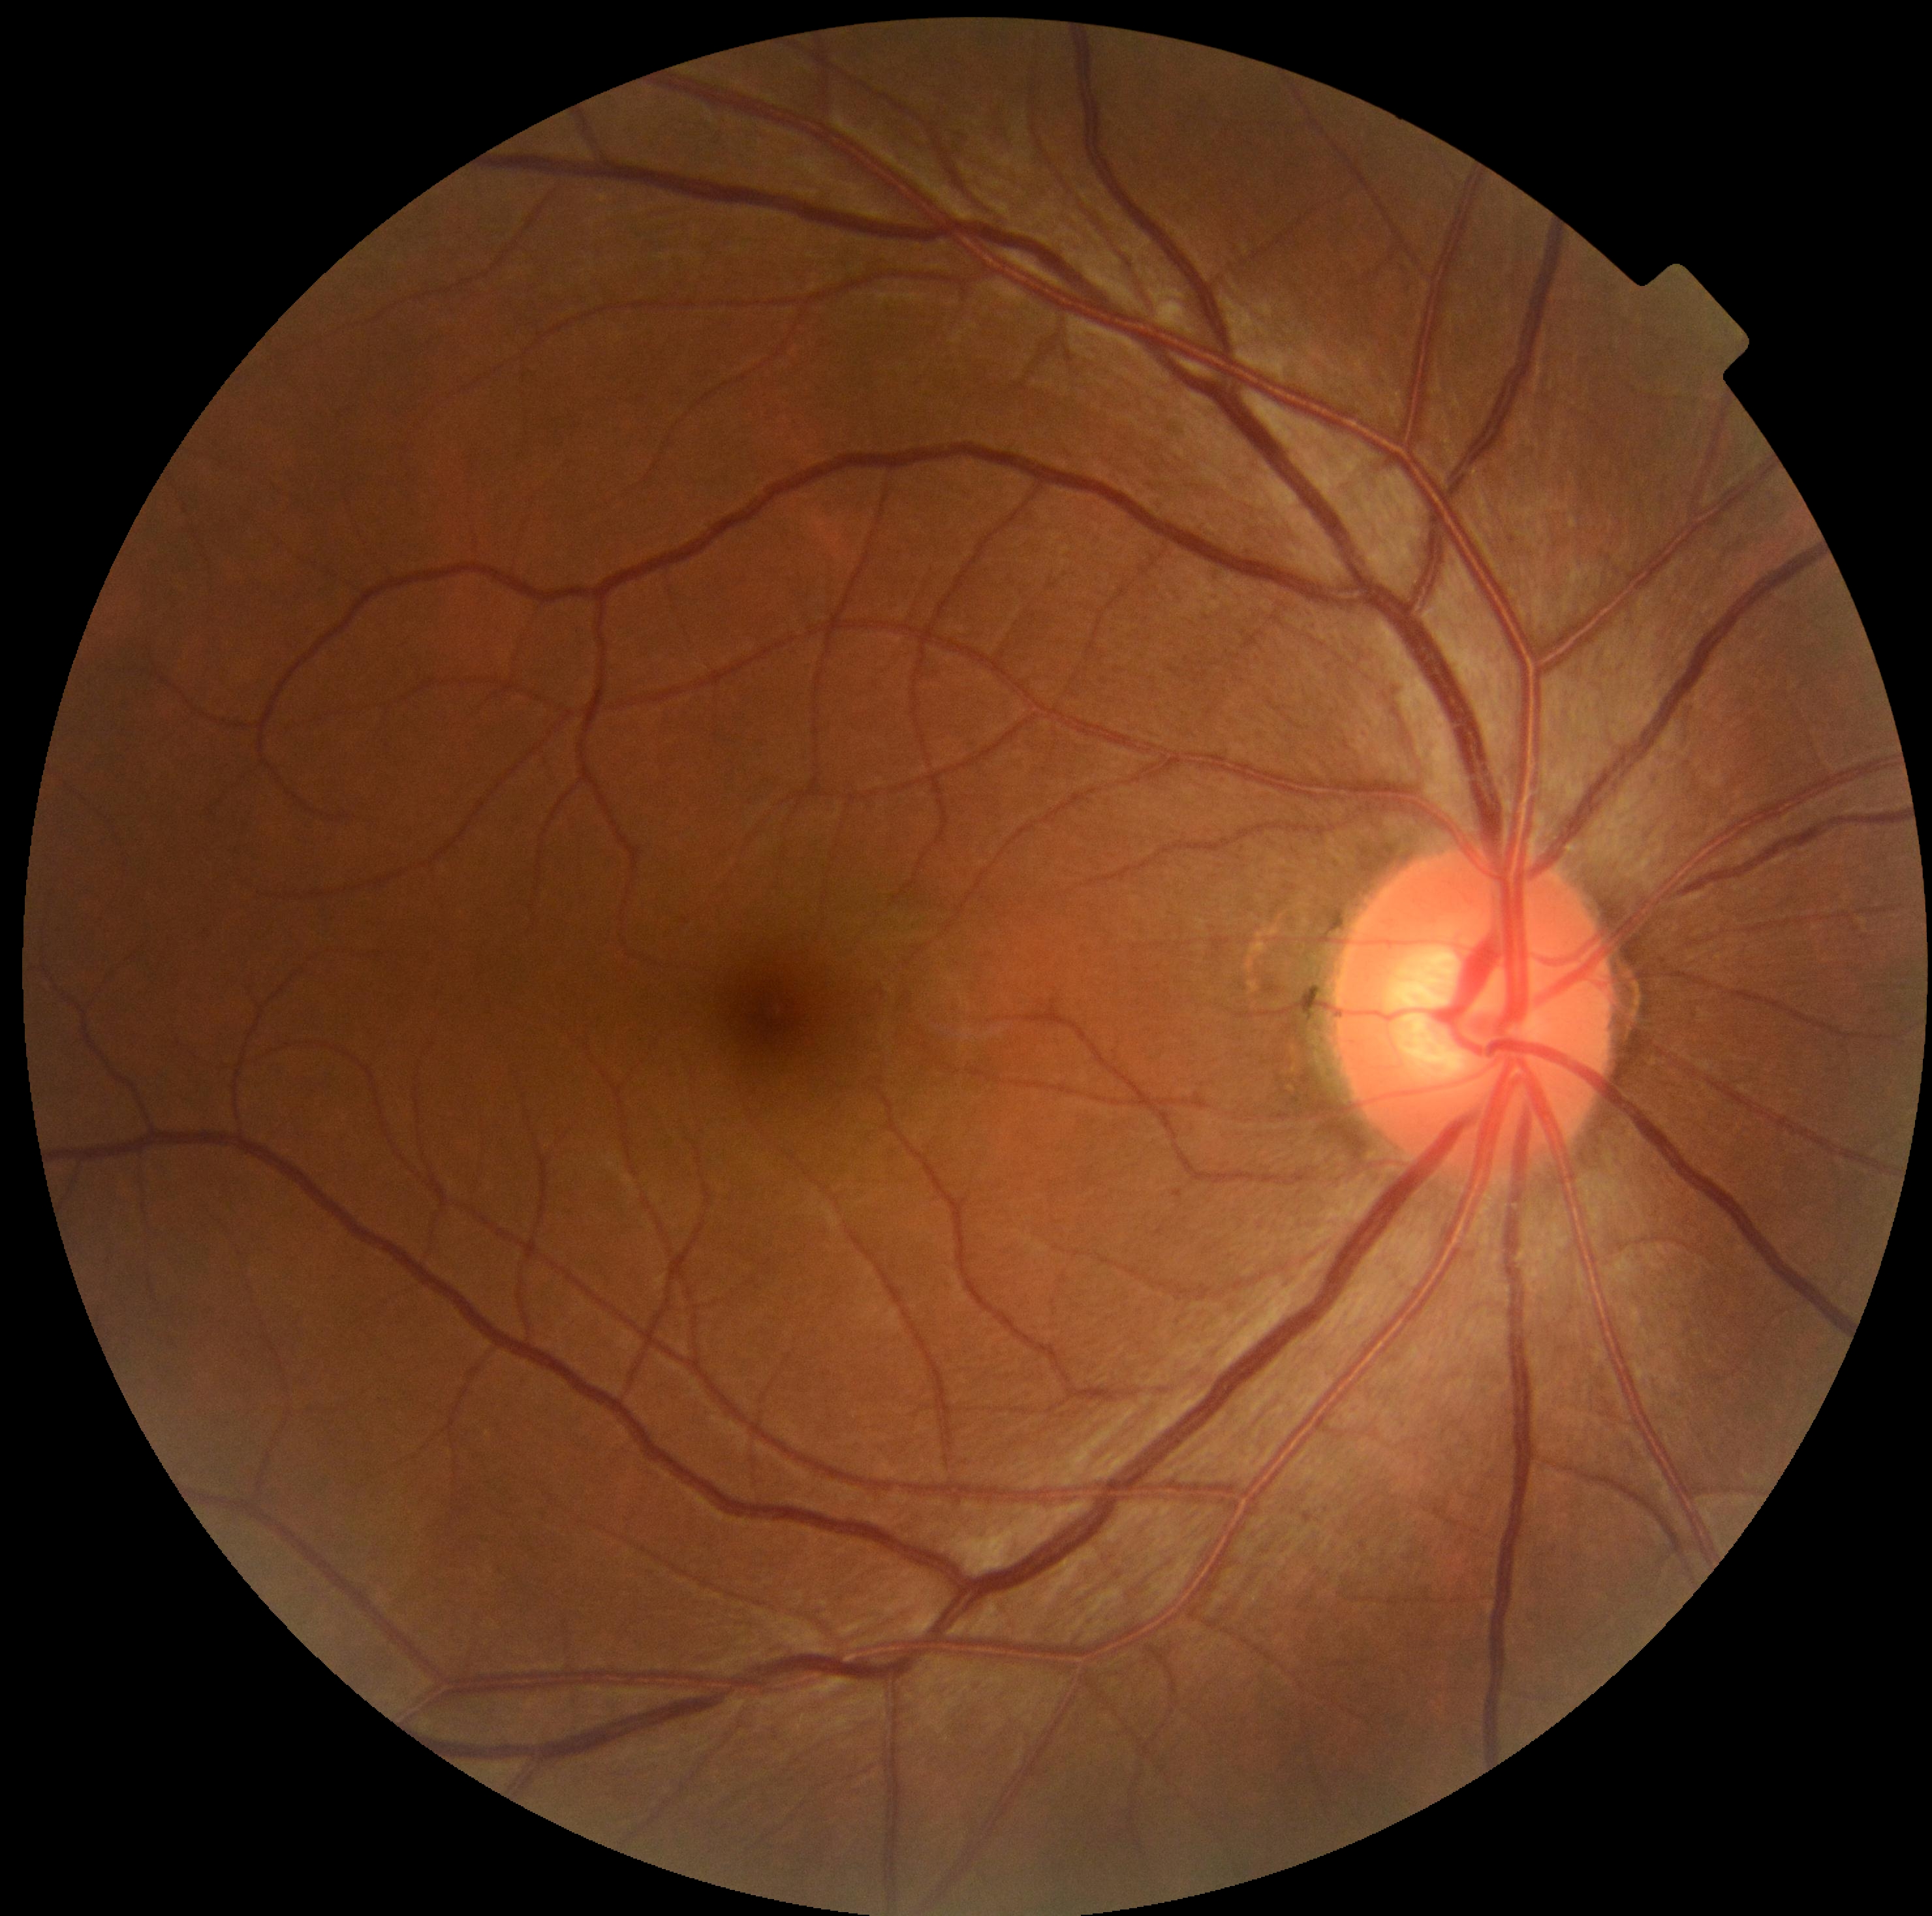 Annotations:
- diabetic retinopathy grade — 0